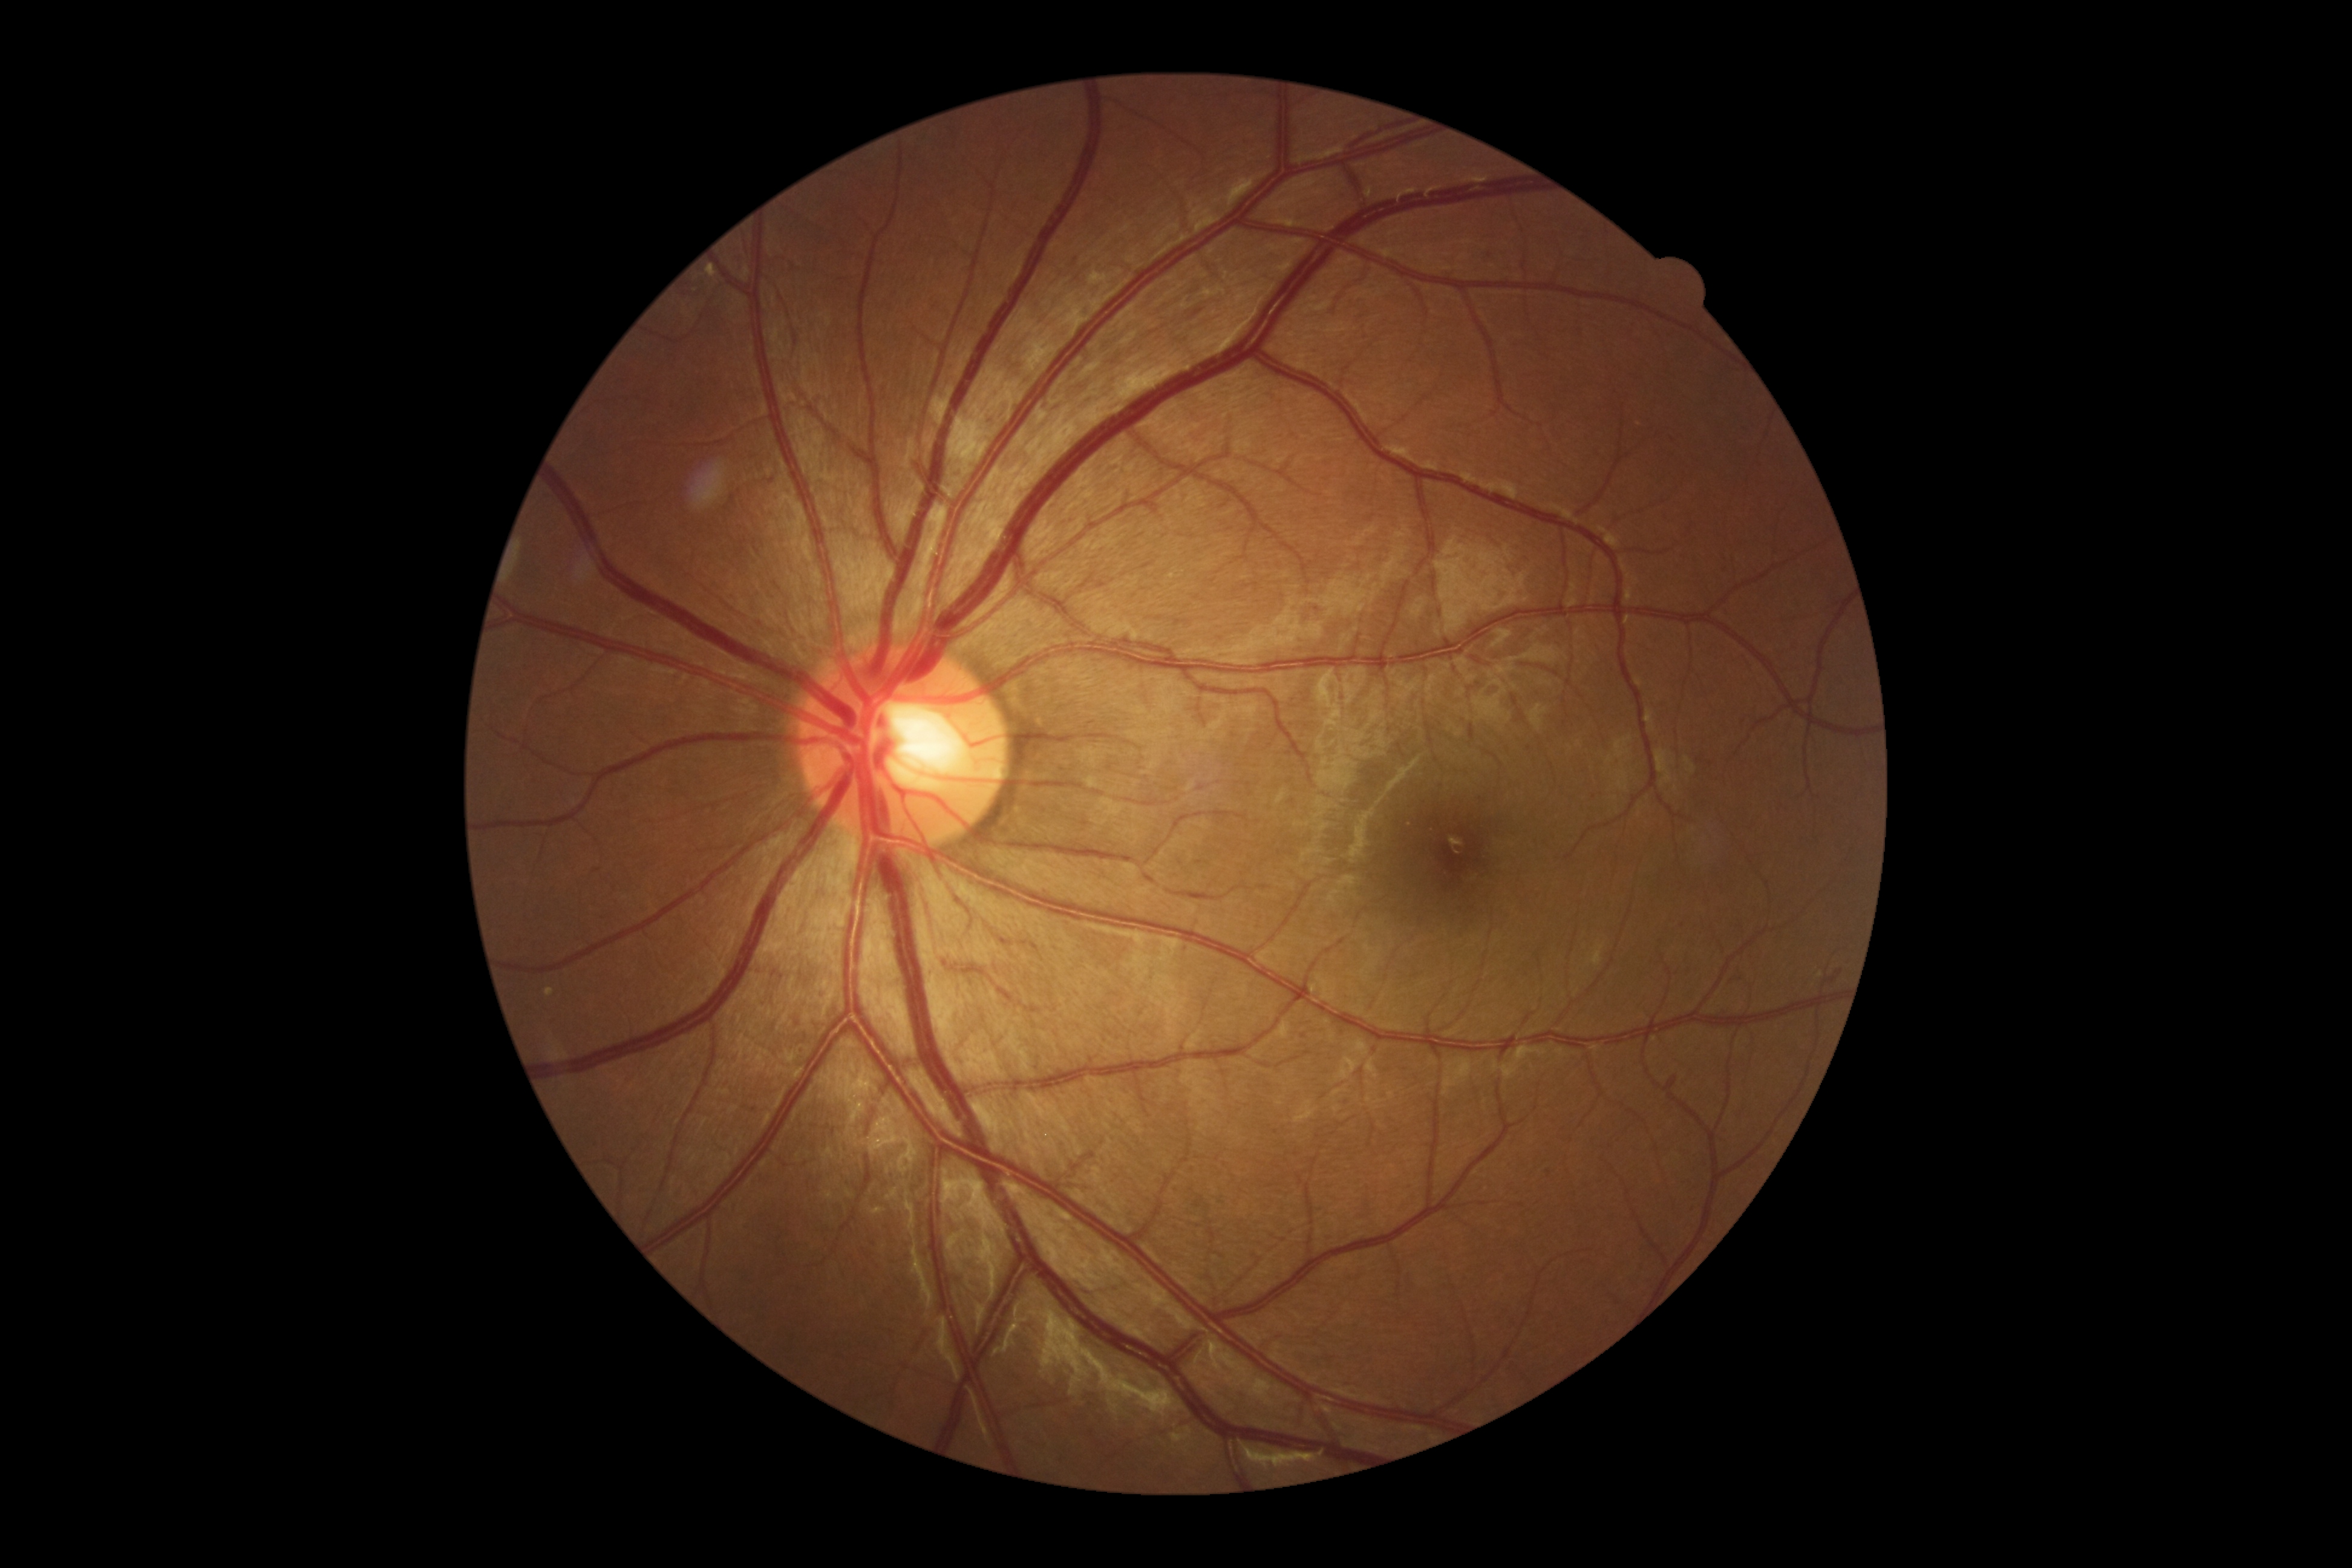 Findings:
– DR — 2 — more than just microaneurysms but less than severe NPDR